Posterior pole view — 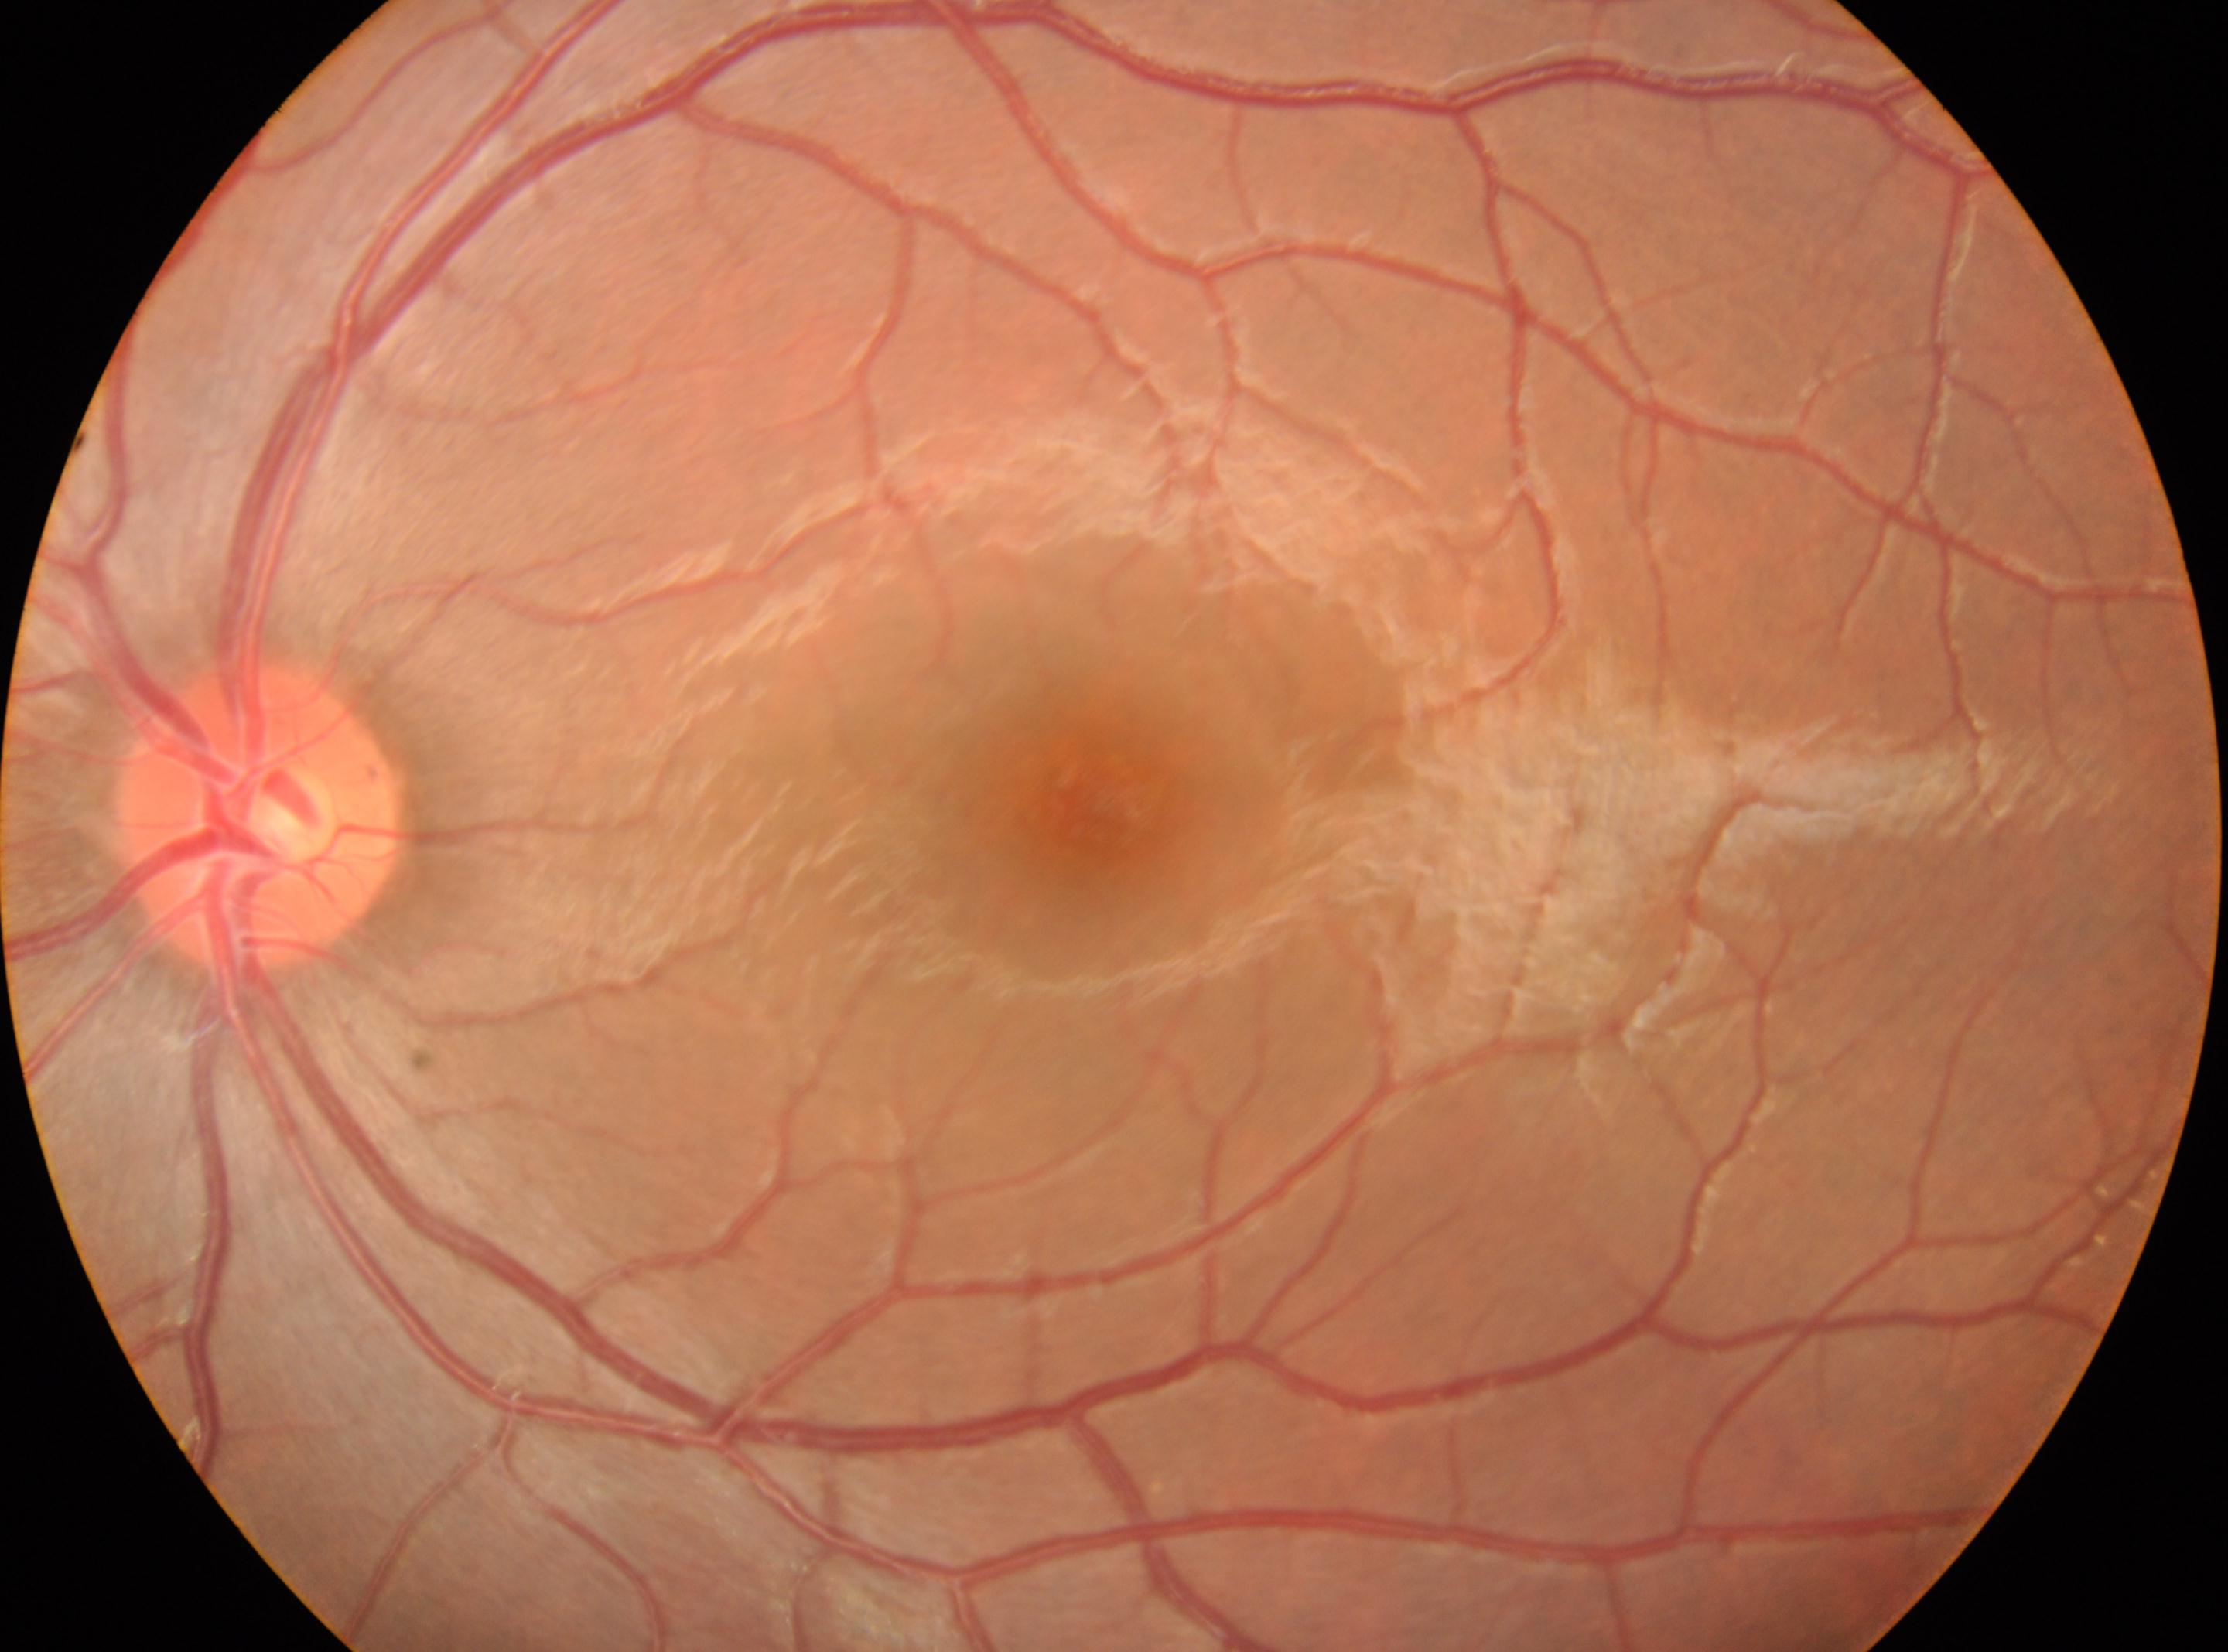
Annotations:
* DR grade: 0 (no apparent retinopathy)
* the optic disc: (258, 817)
* macular center: (1100, 798)
* laterality: left eye